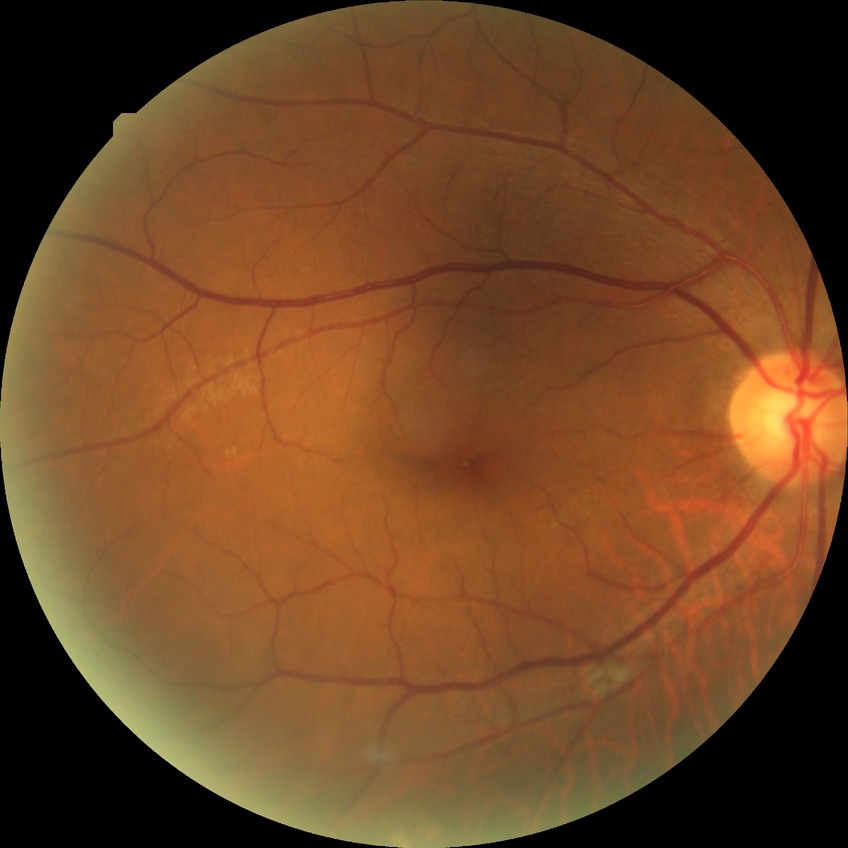

Diabetic retinopathy (DR) is no diabetic retinopathy (NDR).